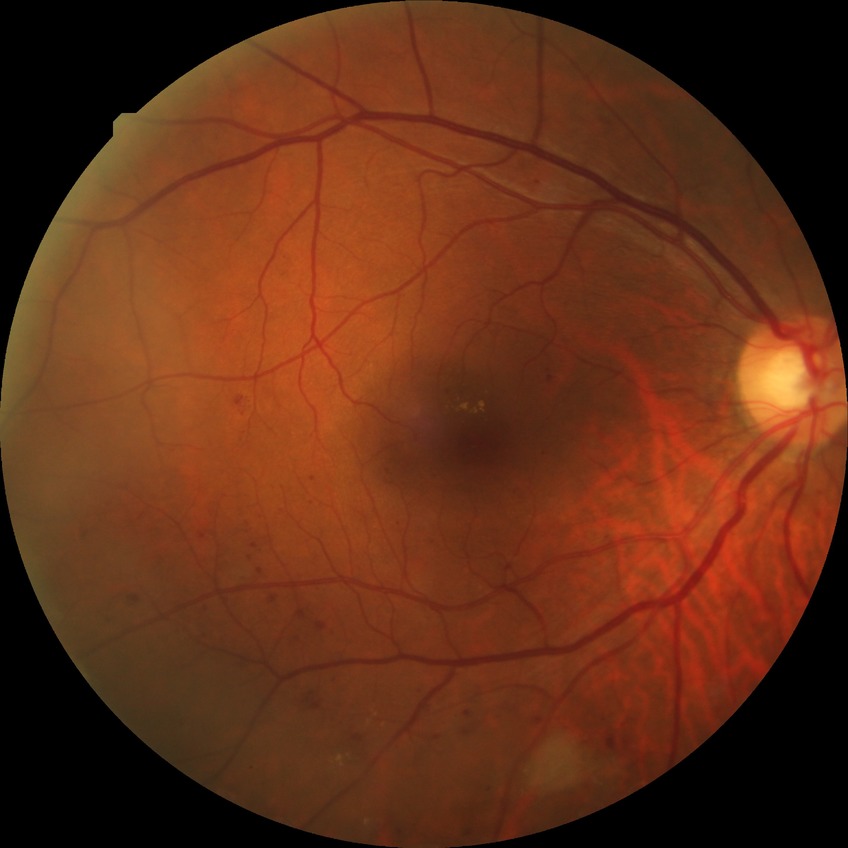 DR grade: PPDR.